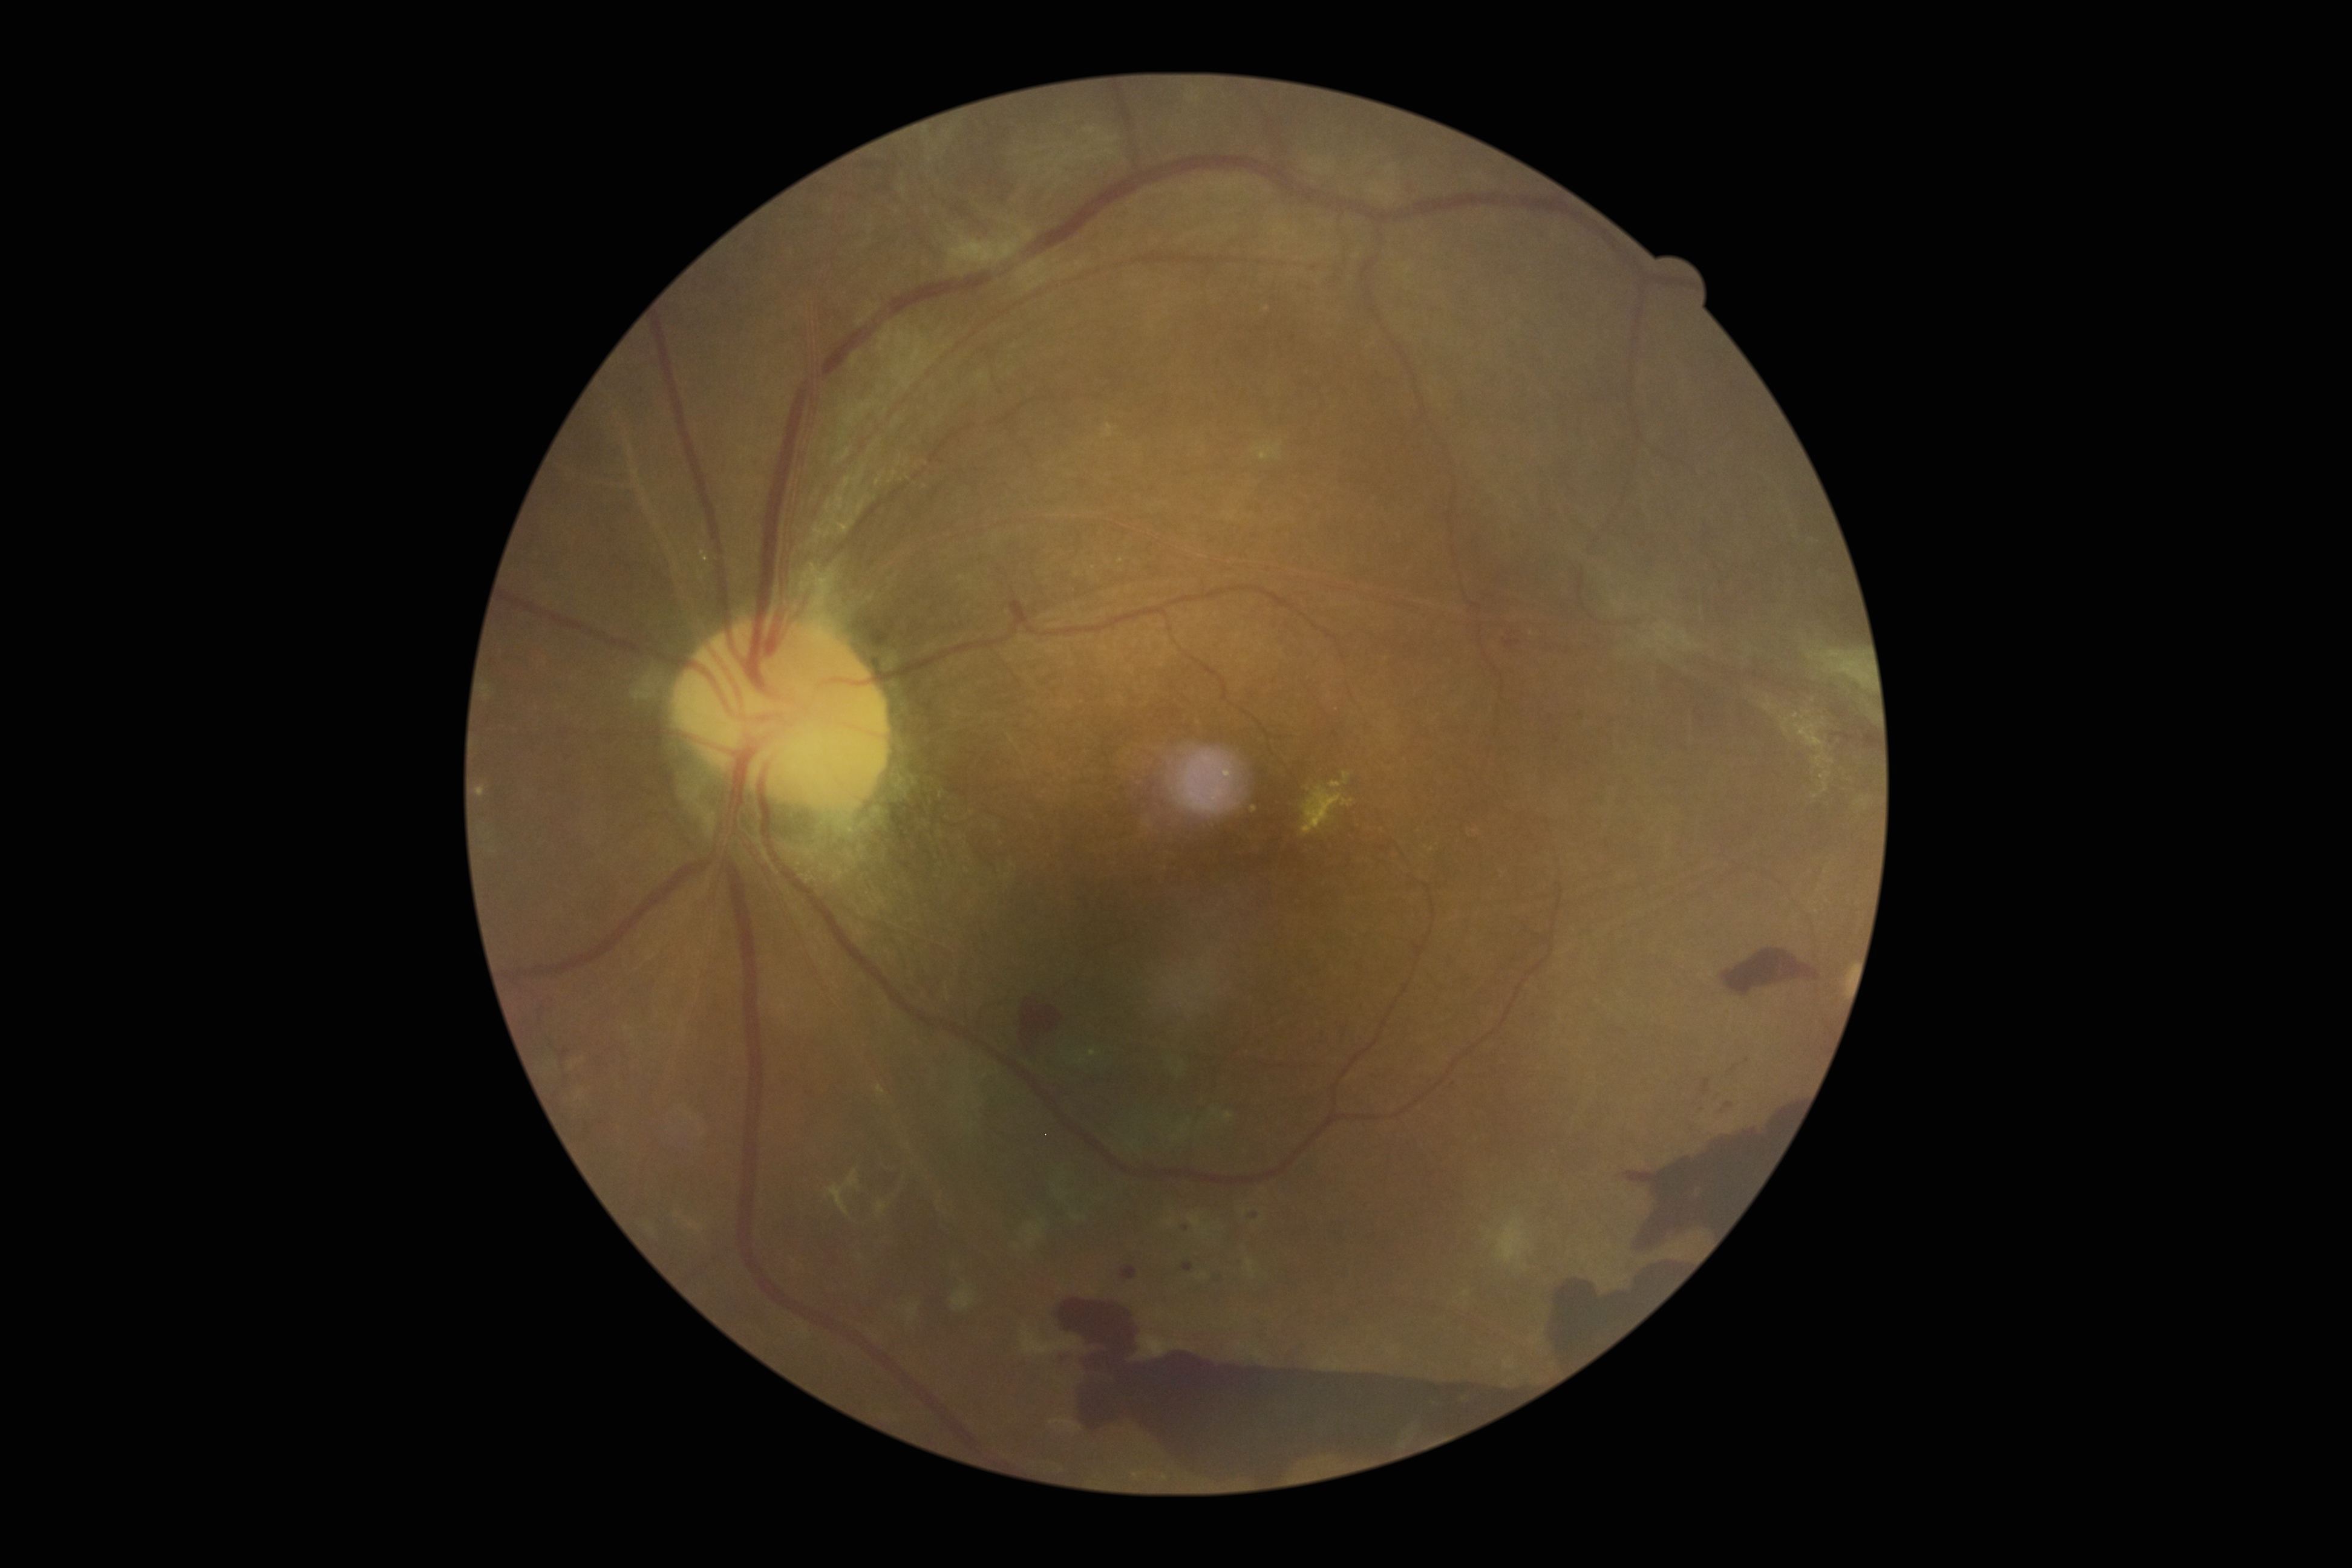

DR is 4/4; proliferative diabetic retinopathy
Lesions identified (partial list):
SEs: none detected
MAs: left=1184, top=1263, right=1194, bottom=1271 | left=1121, top=1266, right=1138, bottom=1279
MAs (small, approximate centers) near [1187, 1228] | [1256, 1216]
HEs (continued): left=1541, top=1263, right=1687, bottom=1369 | left=1703, top=1079, right=1710, bottom=1094 | left=1715, top=1094, right=1721, bottom=1102 | left=1731, top=1065, right=1738, bottom=1073 | left=1506, top=641, right=1520, bottom=649 | left=1618, top=1111, right=1798, bottom=1256 | left=1721, top=949, right=1820, bottom=996 | left=1056, top=1302, right=1537, bottom=1483 | left=1007, top=1005, right=1065, bottom=1058
HEs (small, approximate centers) near [1729, 1104]
EXs: left=1302, top=785, right=1354, bottom=835 | left=1330, top=771, right=1351, bottom=789 | left=1252, top=806, right=1258, bottom=814